Wide-field contact fundus photograph of an infant — 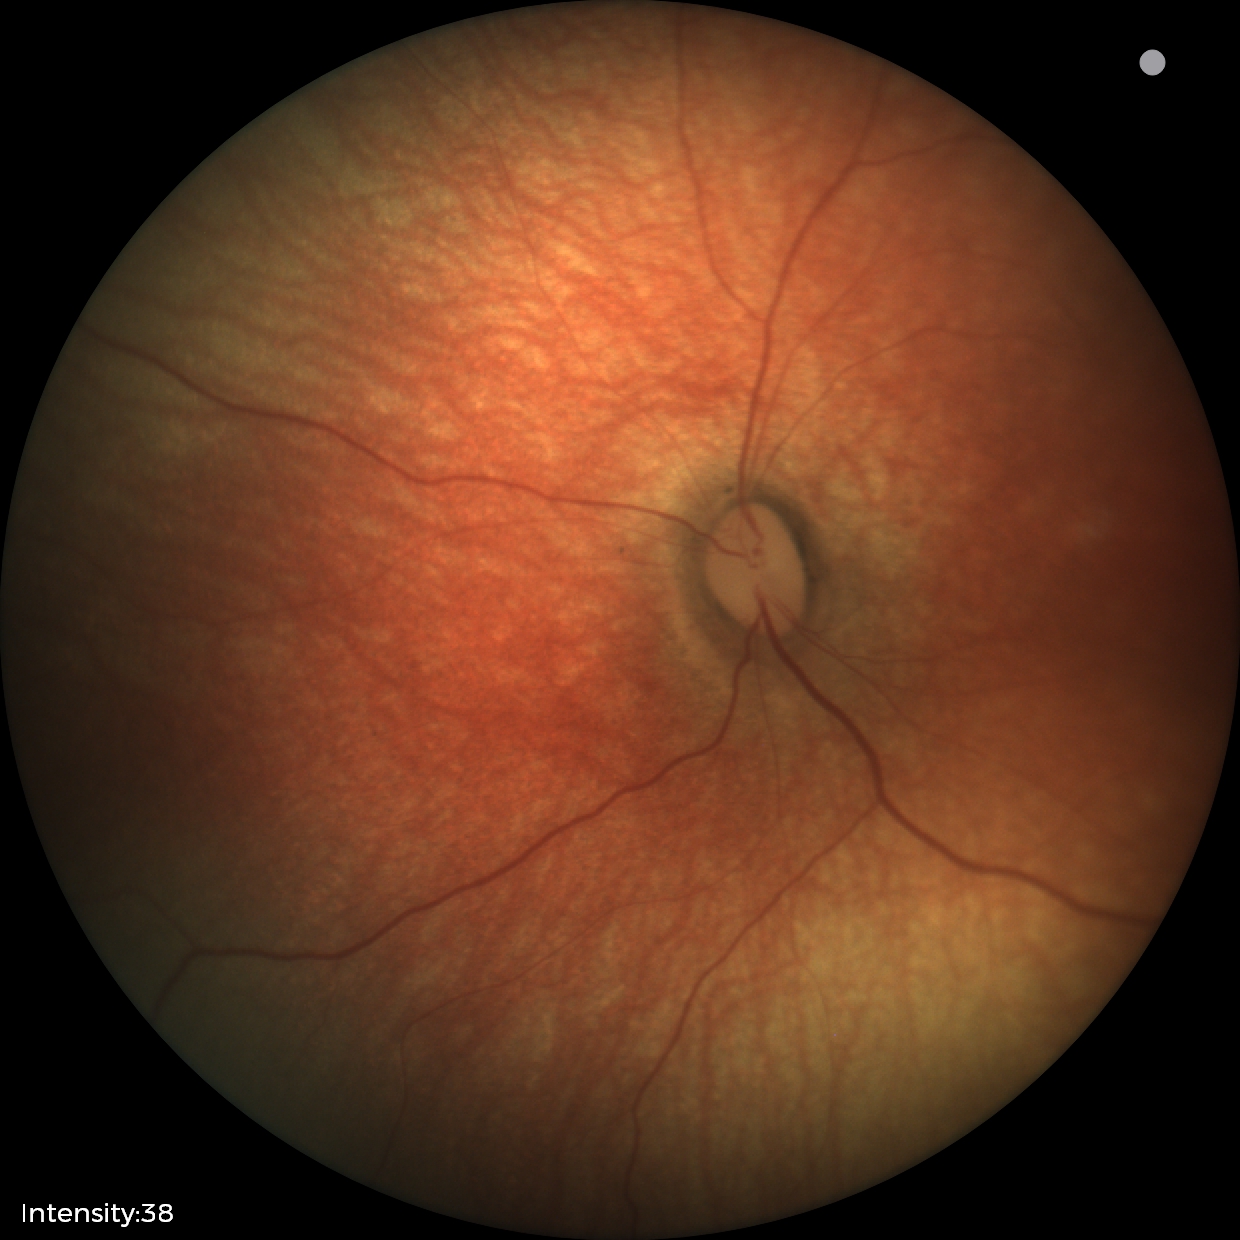
Finding = physiological